Ultra-widefield (UWF) fundus image · 1924x1556.
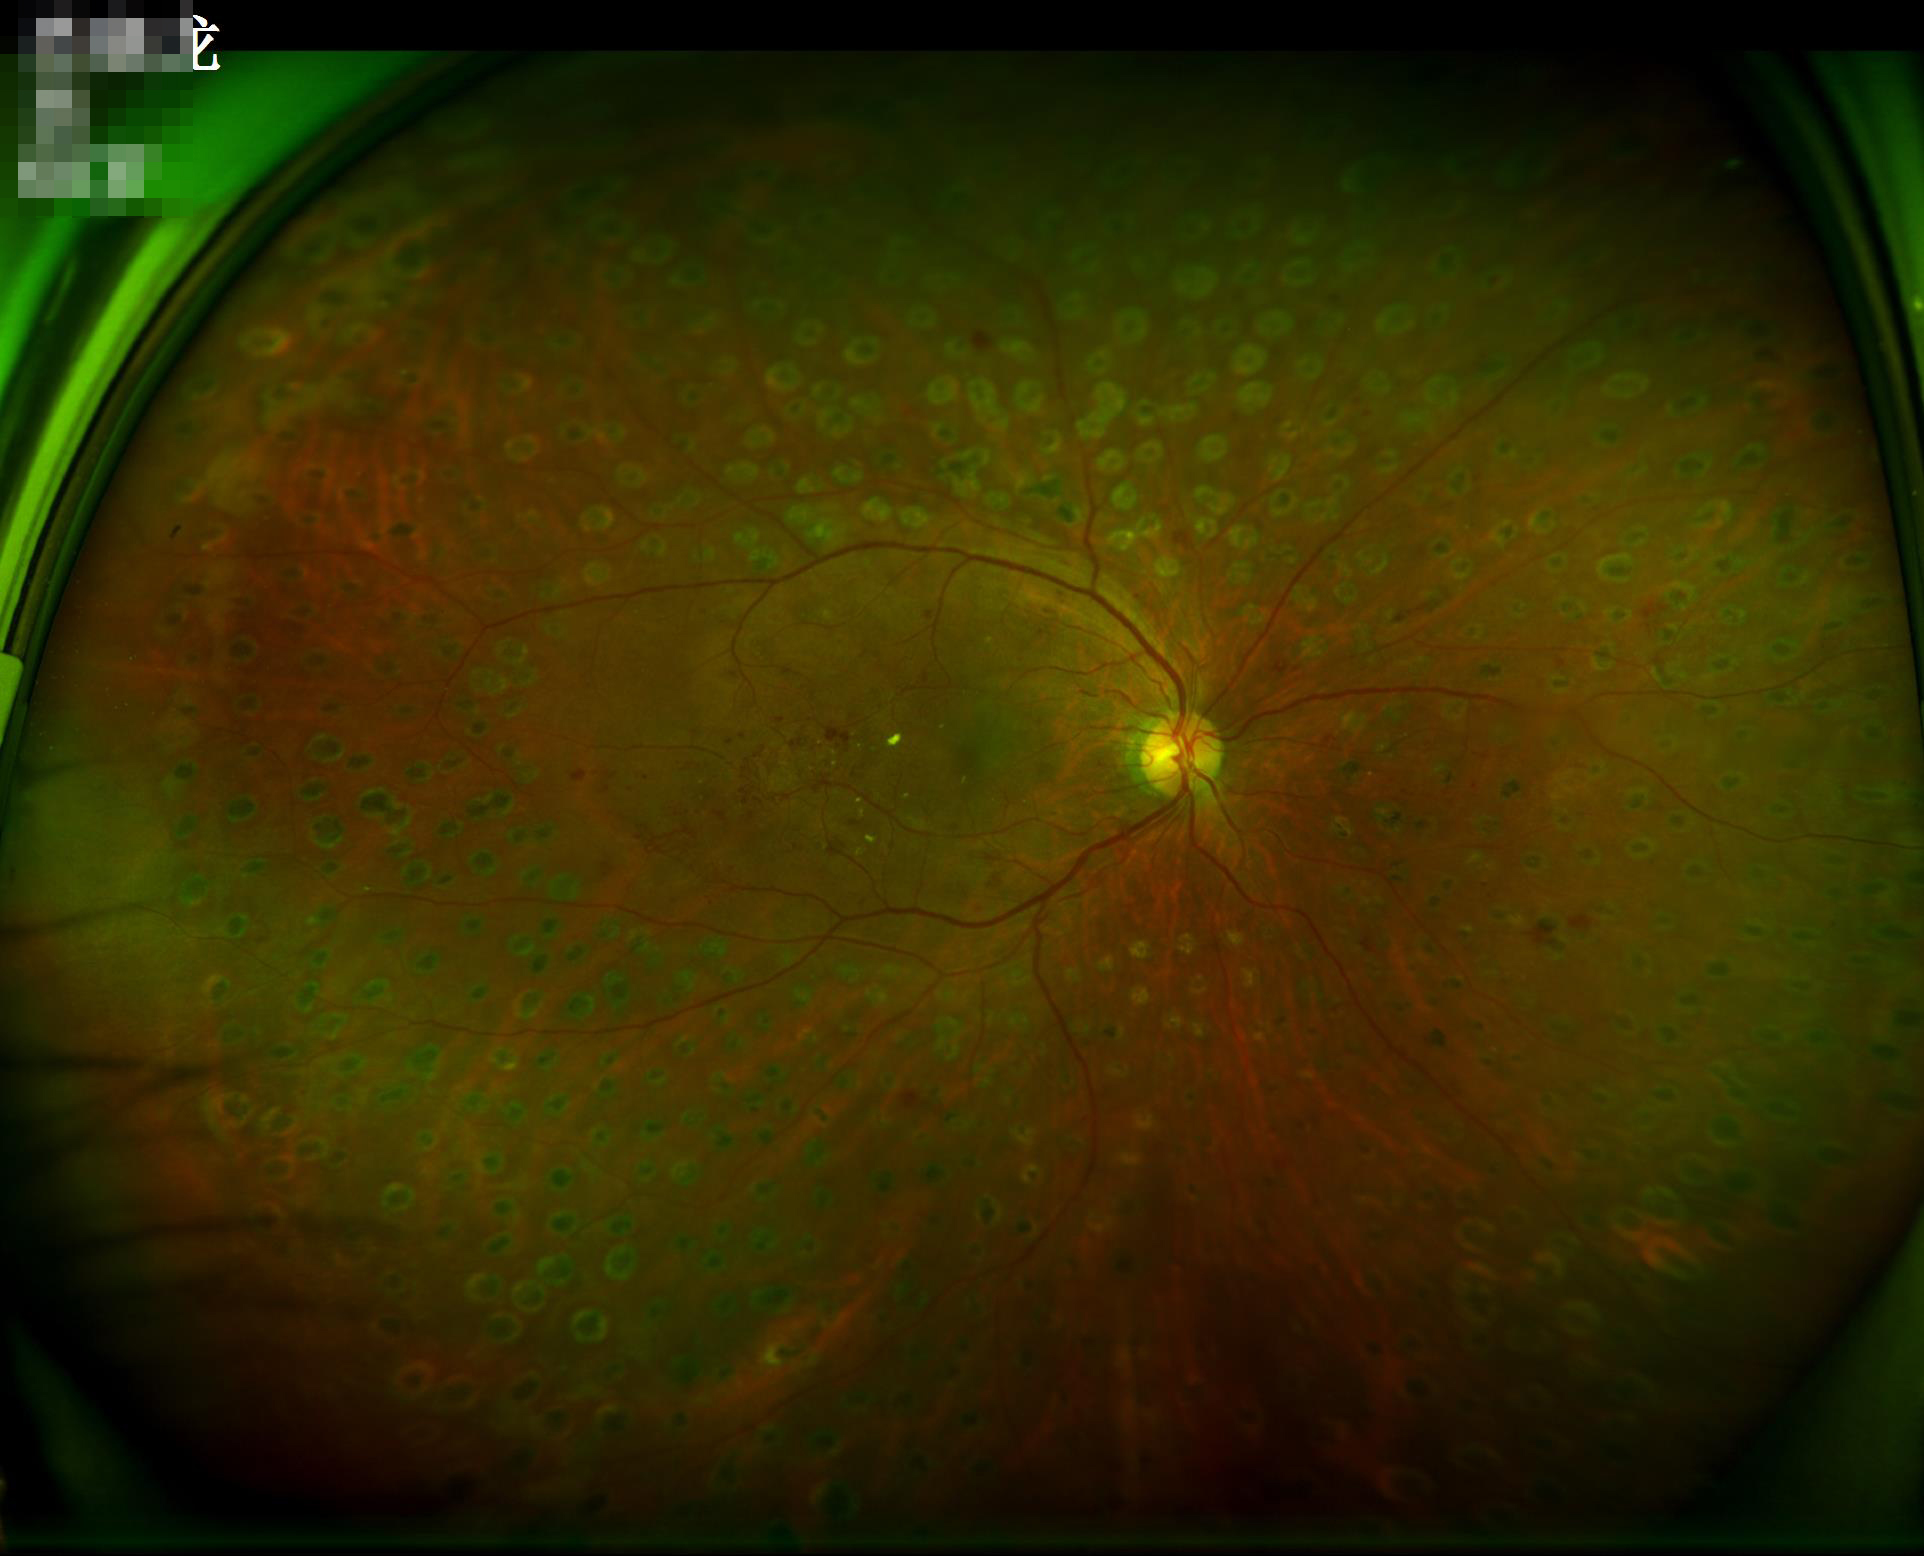

Quality grading: overall: good, gradable; illumination: uniform, no color cast; contrast: vessels and details readily distinguishable; focus: clear with no noticeable blur.